Without pupil dilation; 45° FOV
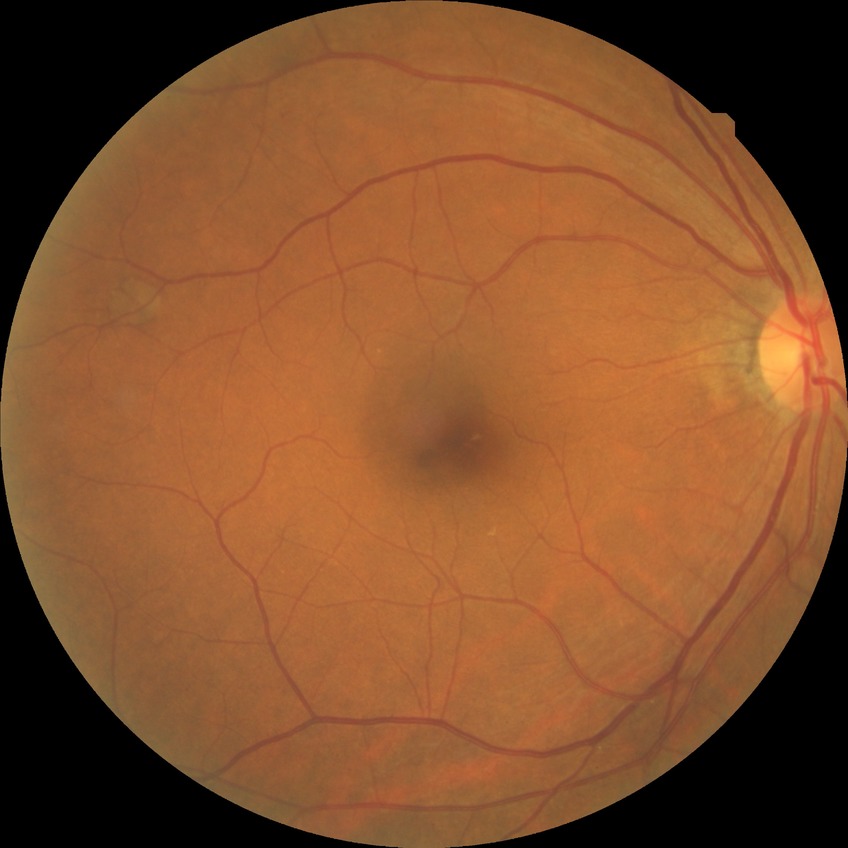 Davis DR grade: NDR.